Modified Davis classification: 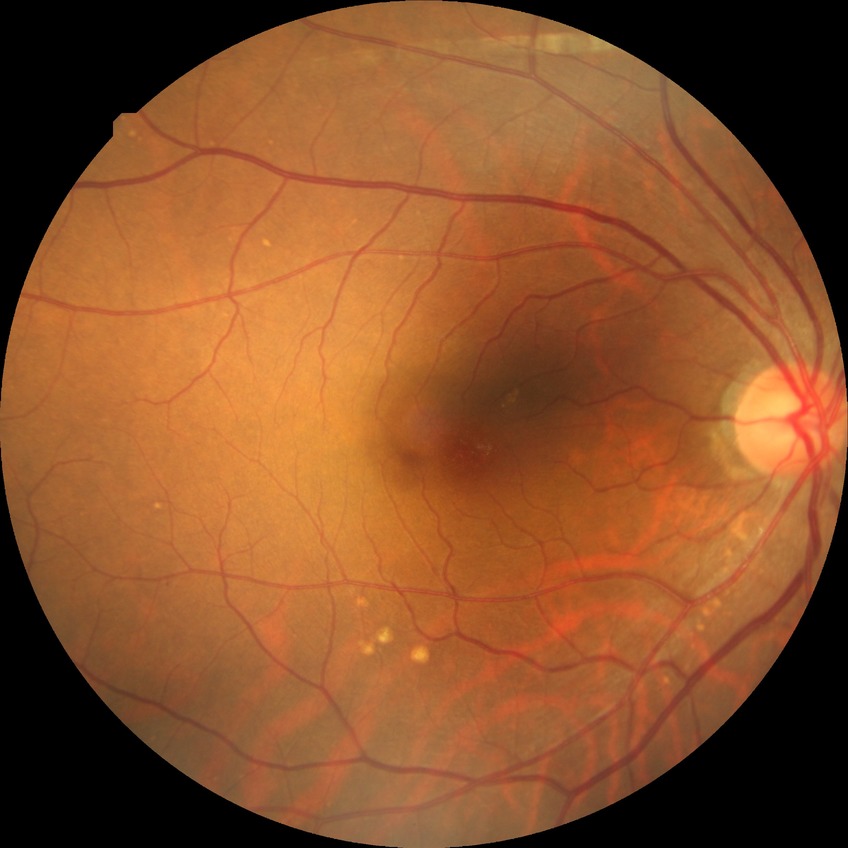 DR: NDR.